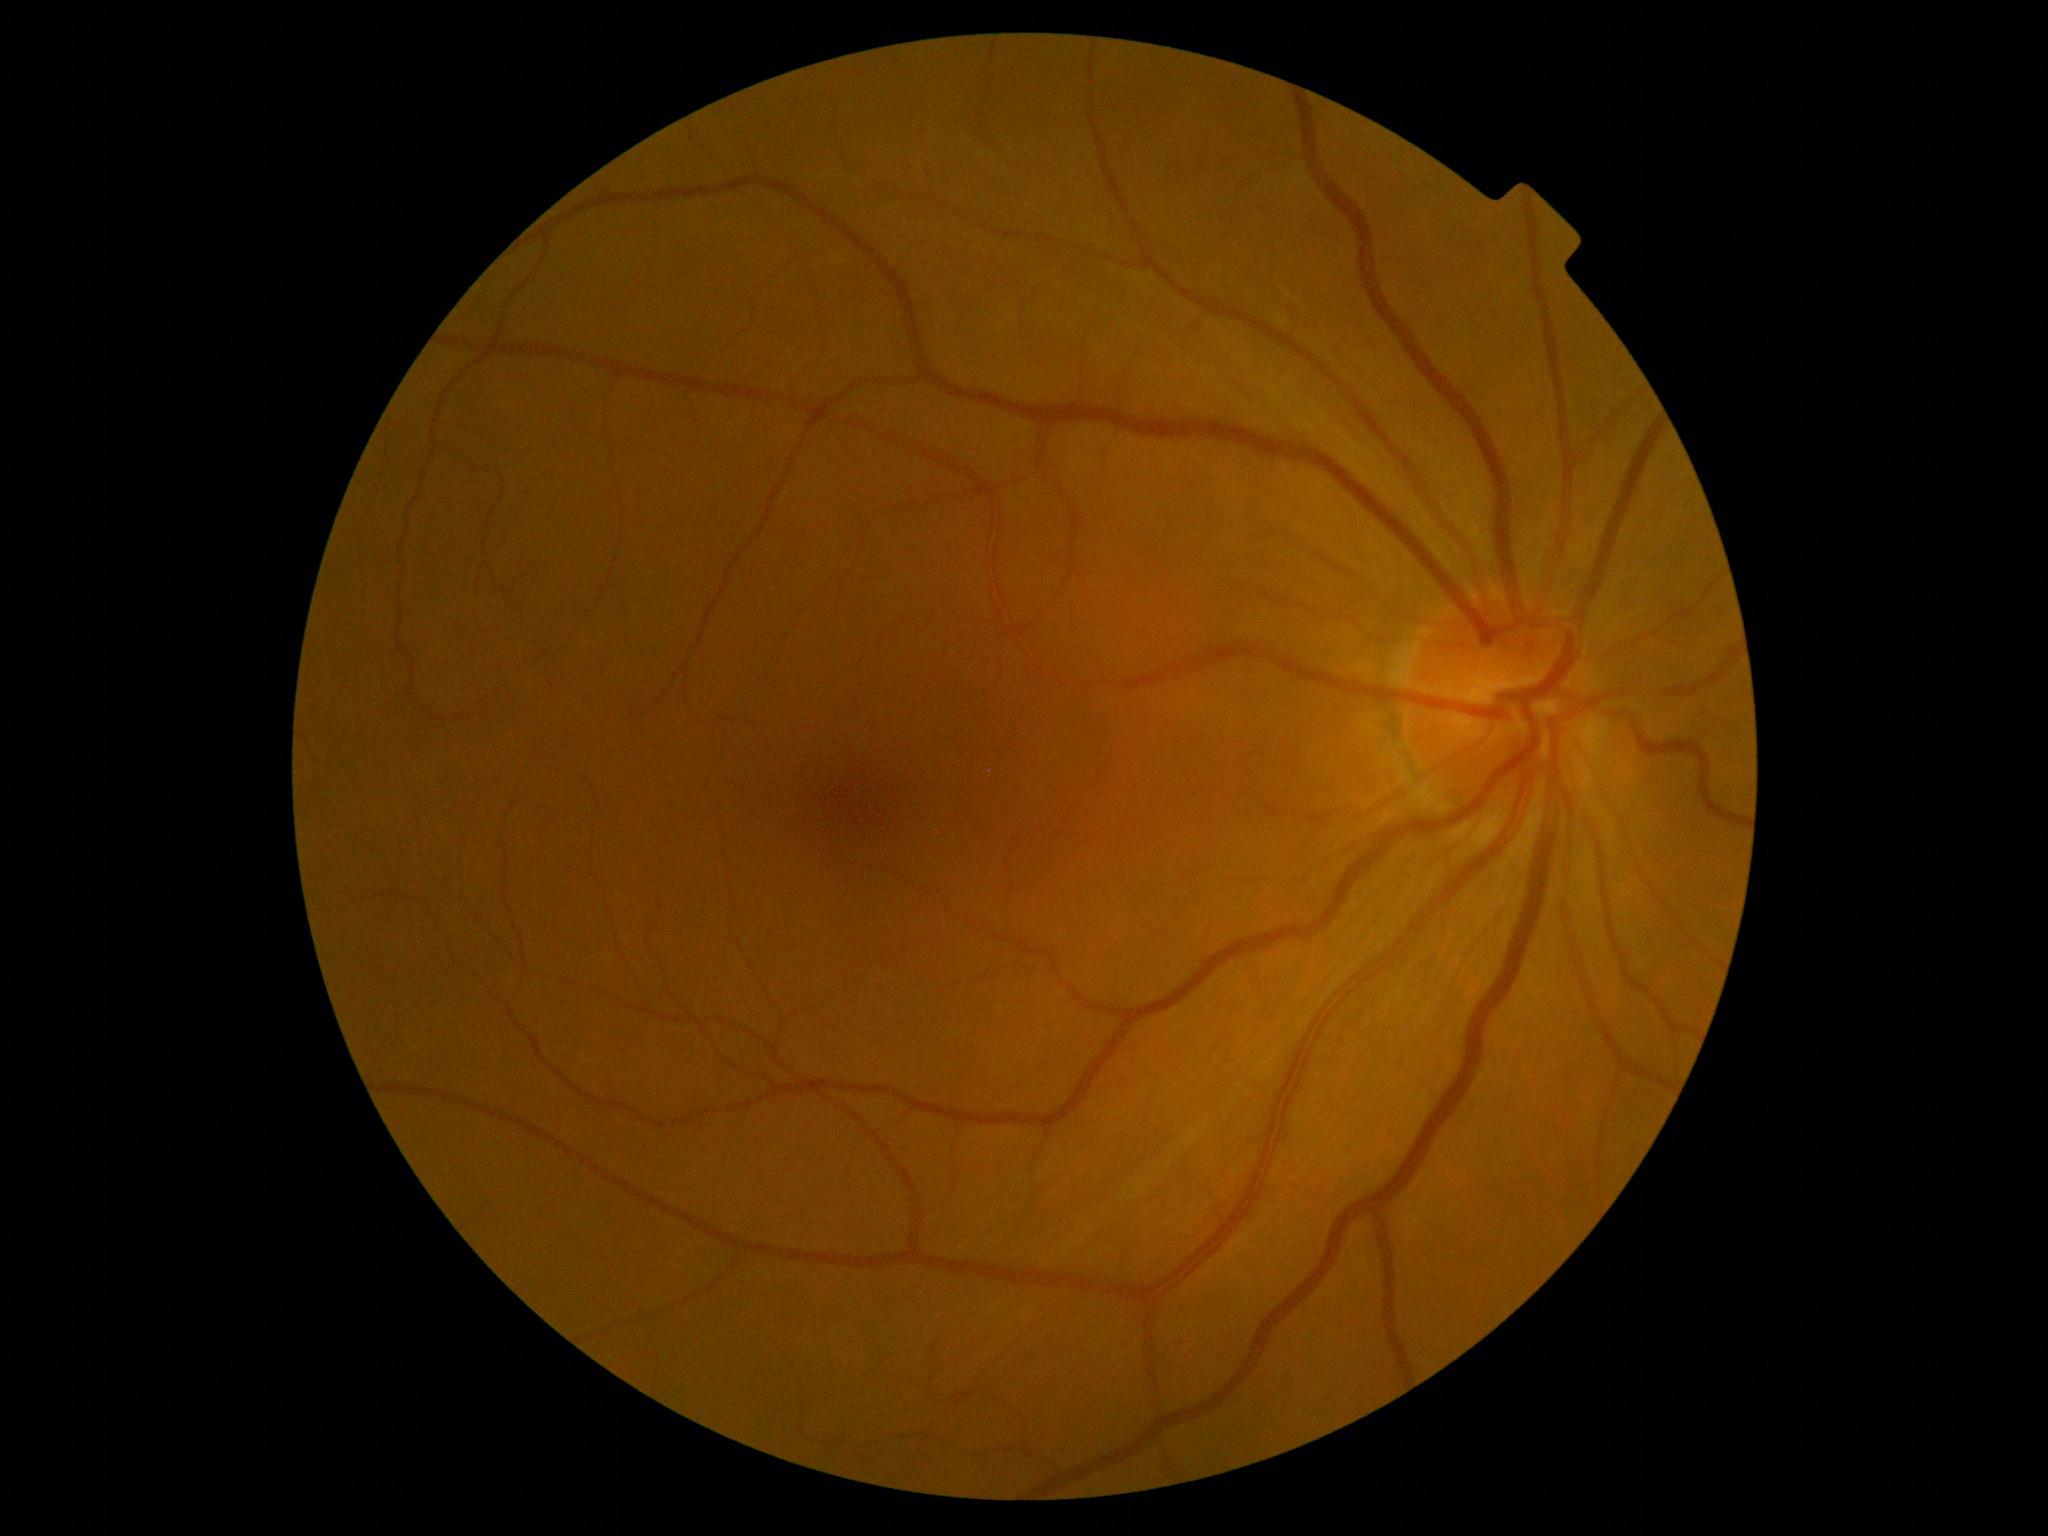
* DR stage — 0/4